Diabetic retinopathy graded by the modified Davis classification — 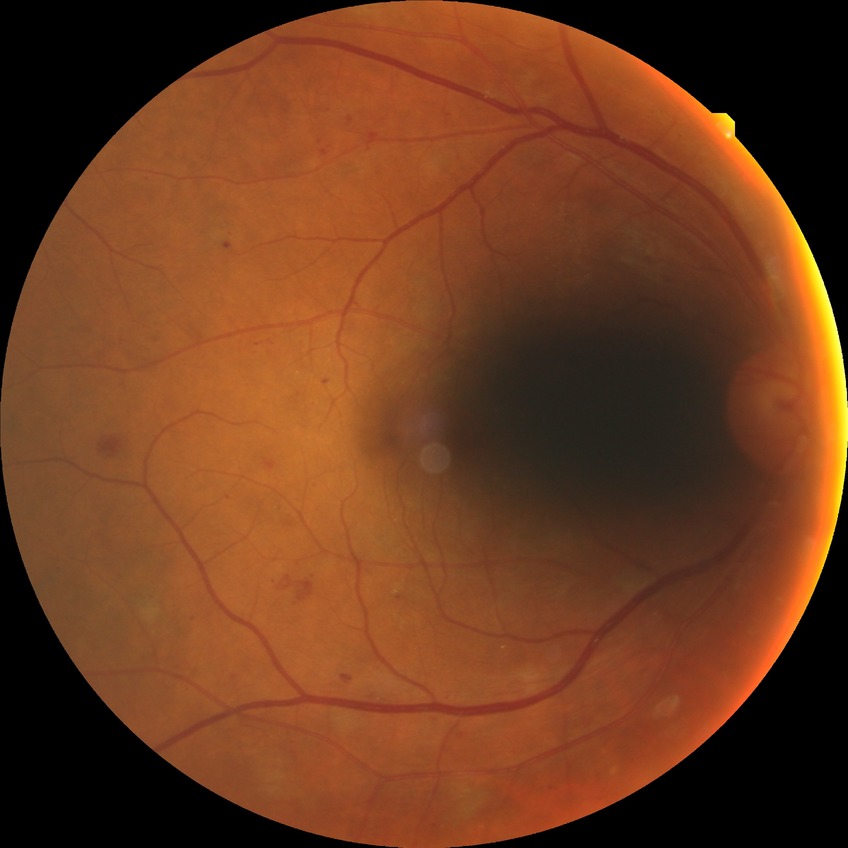 Modified Davis grading is simple diabetic retinopathy.
DR class: non-proliferative diabetic retinopathy.